2352 by 1568 pixels
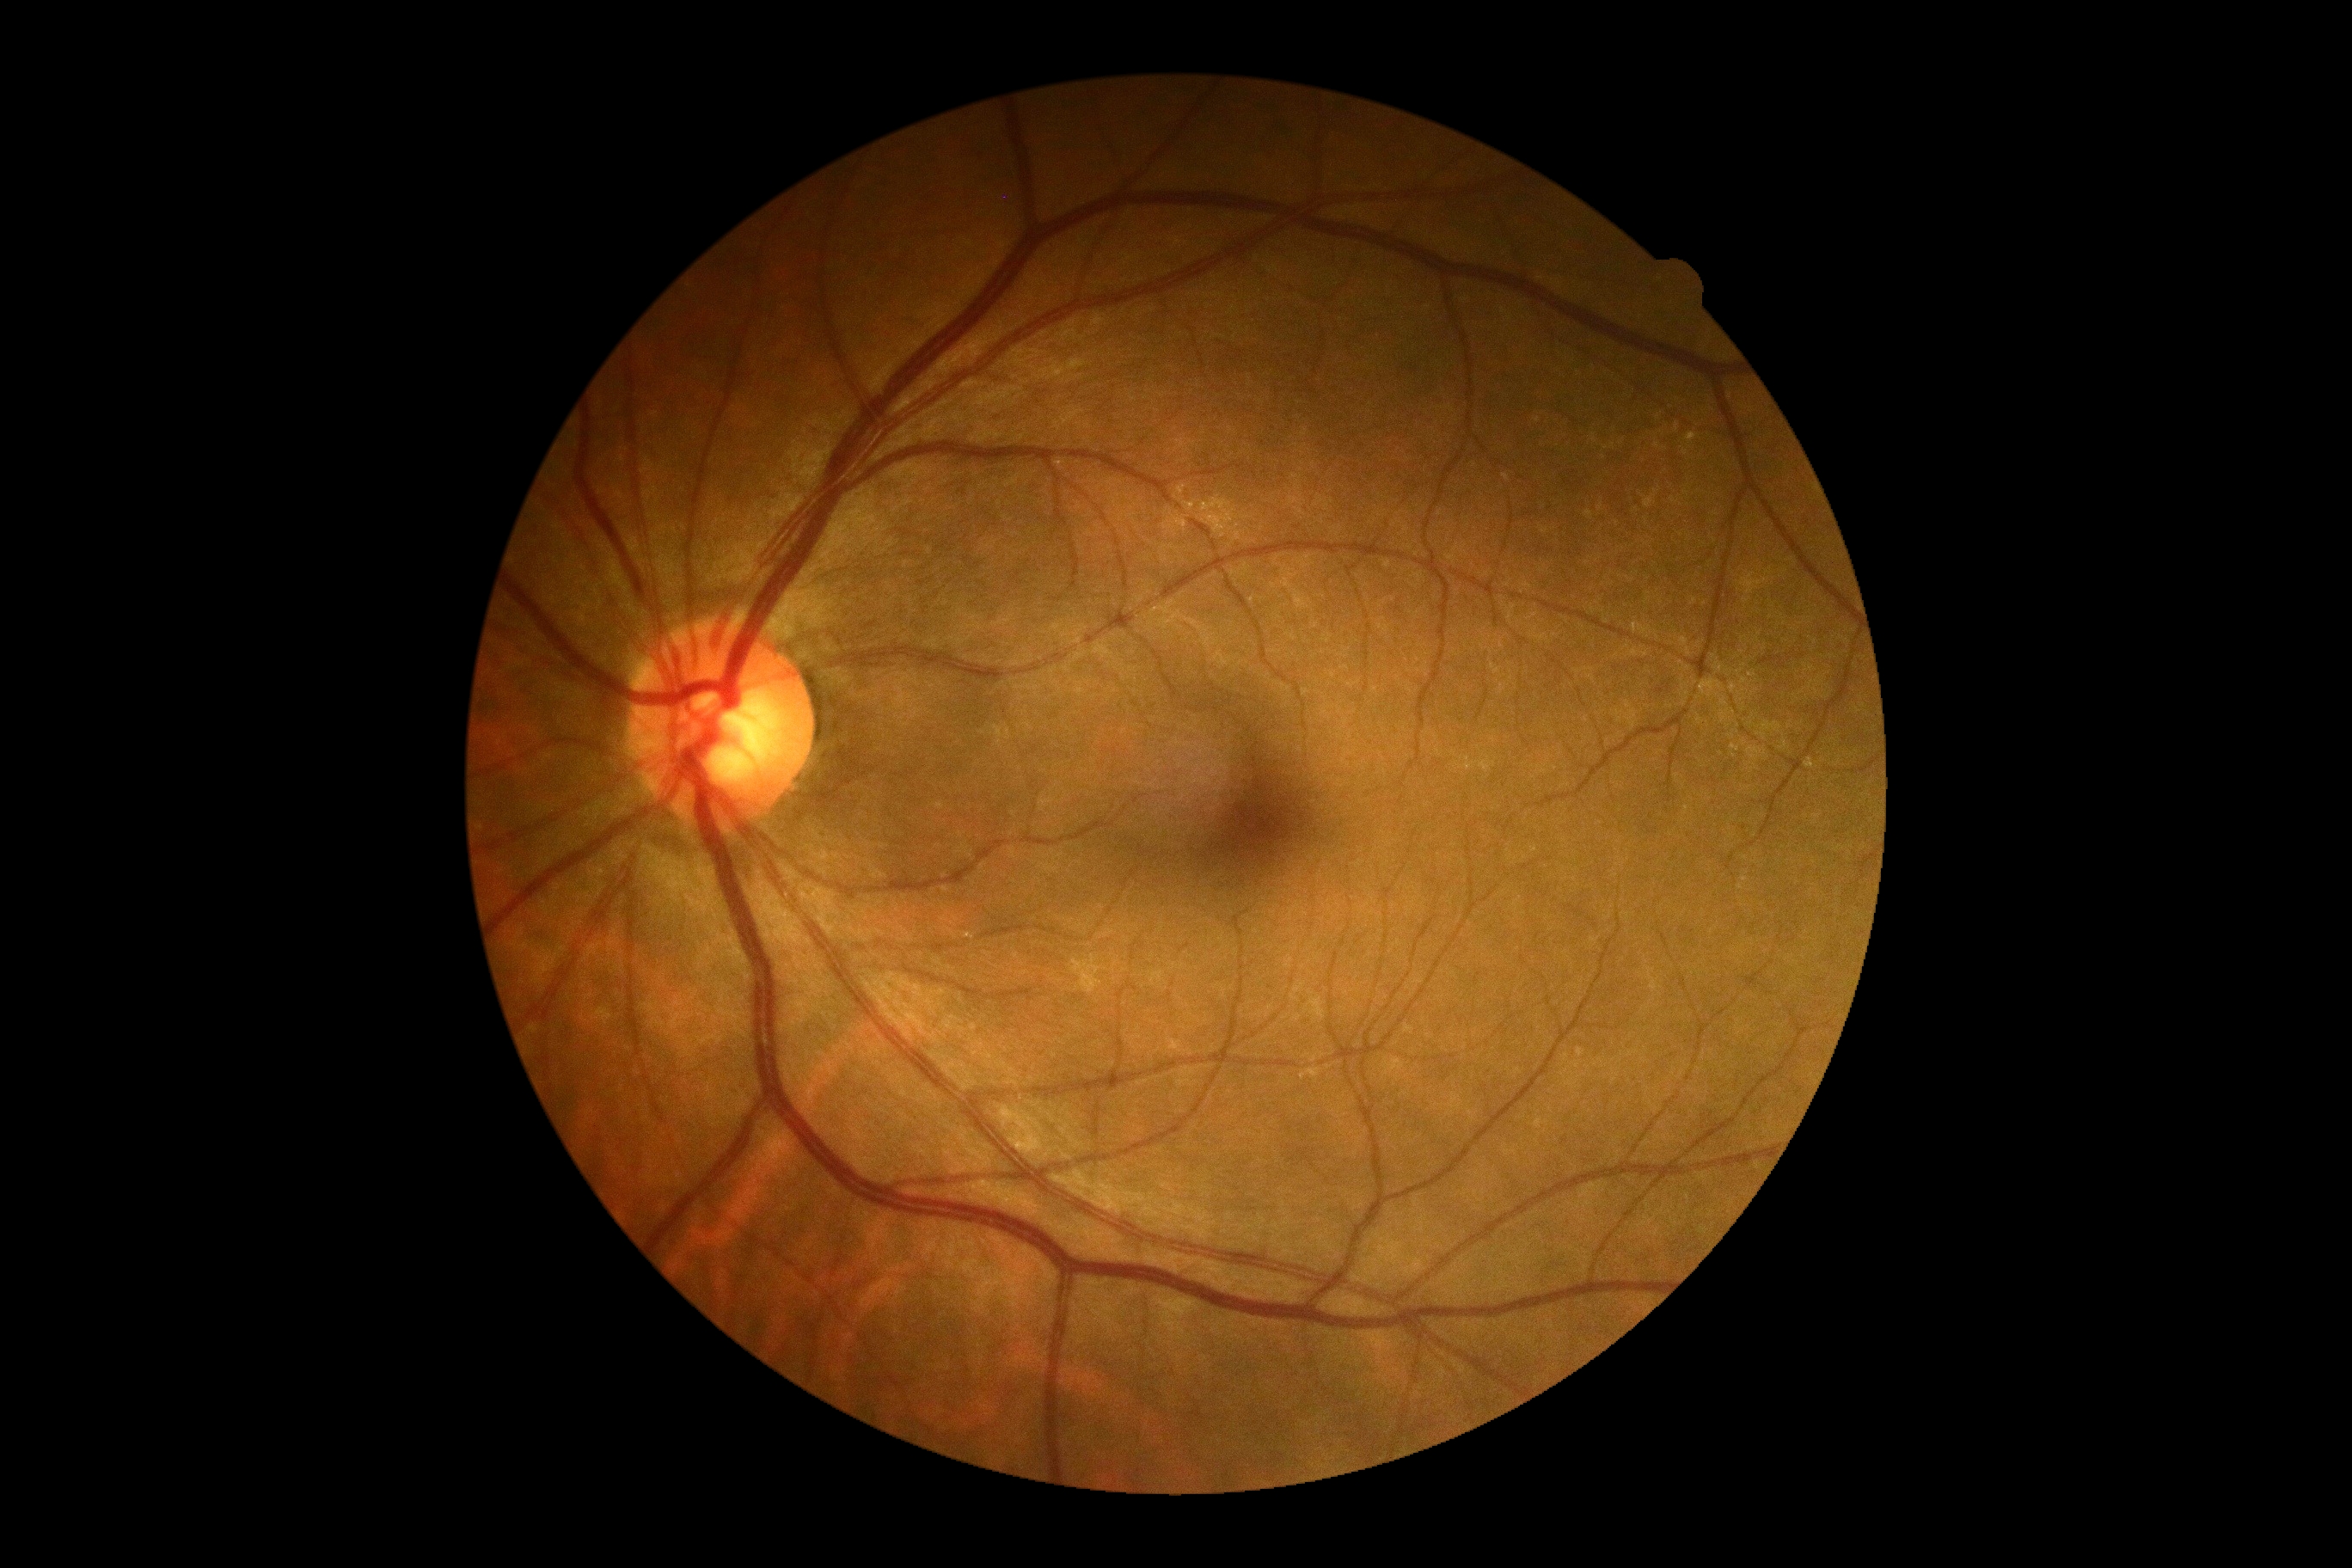 Retinopathy is 0.